50-degree field of view — 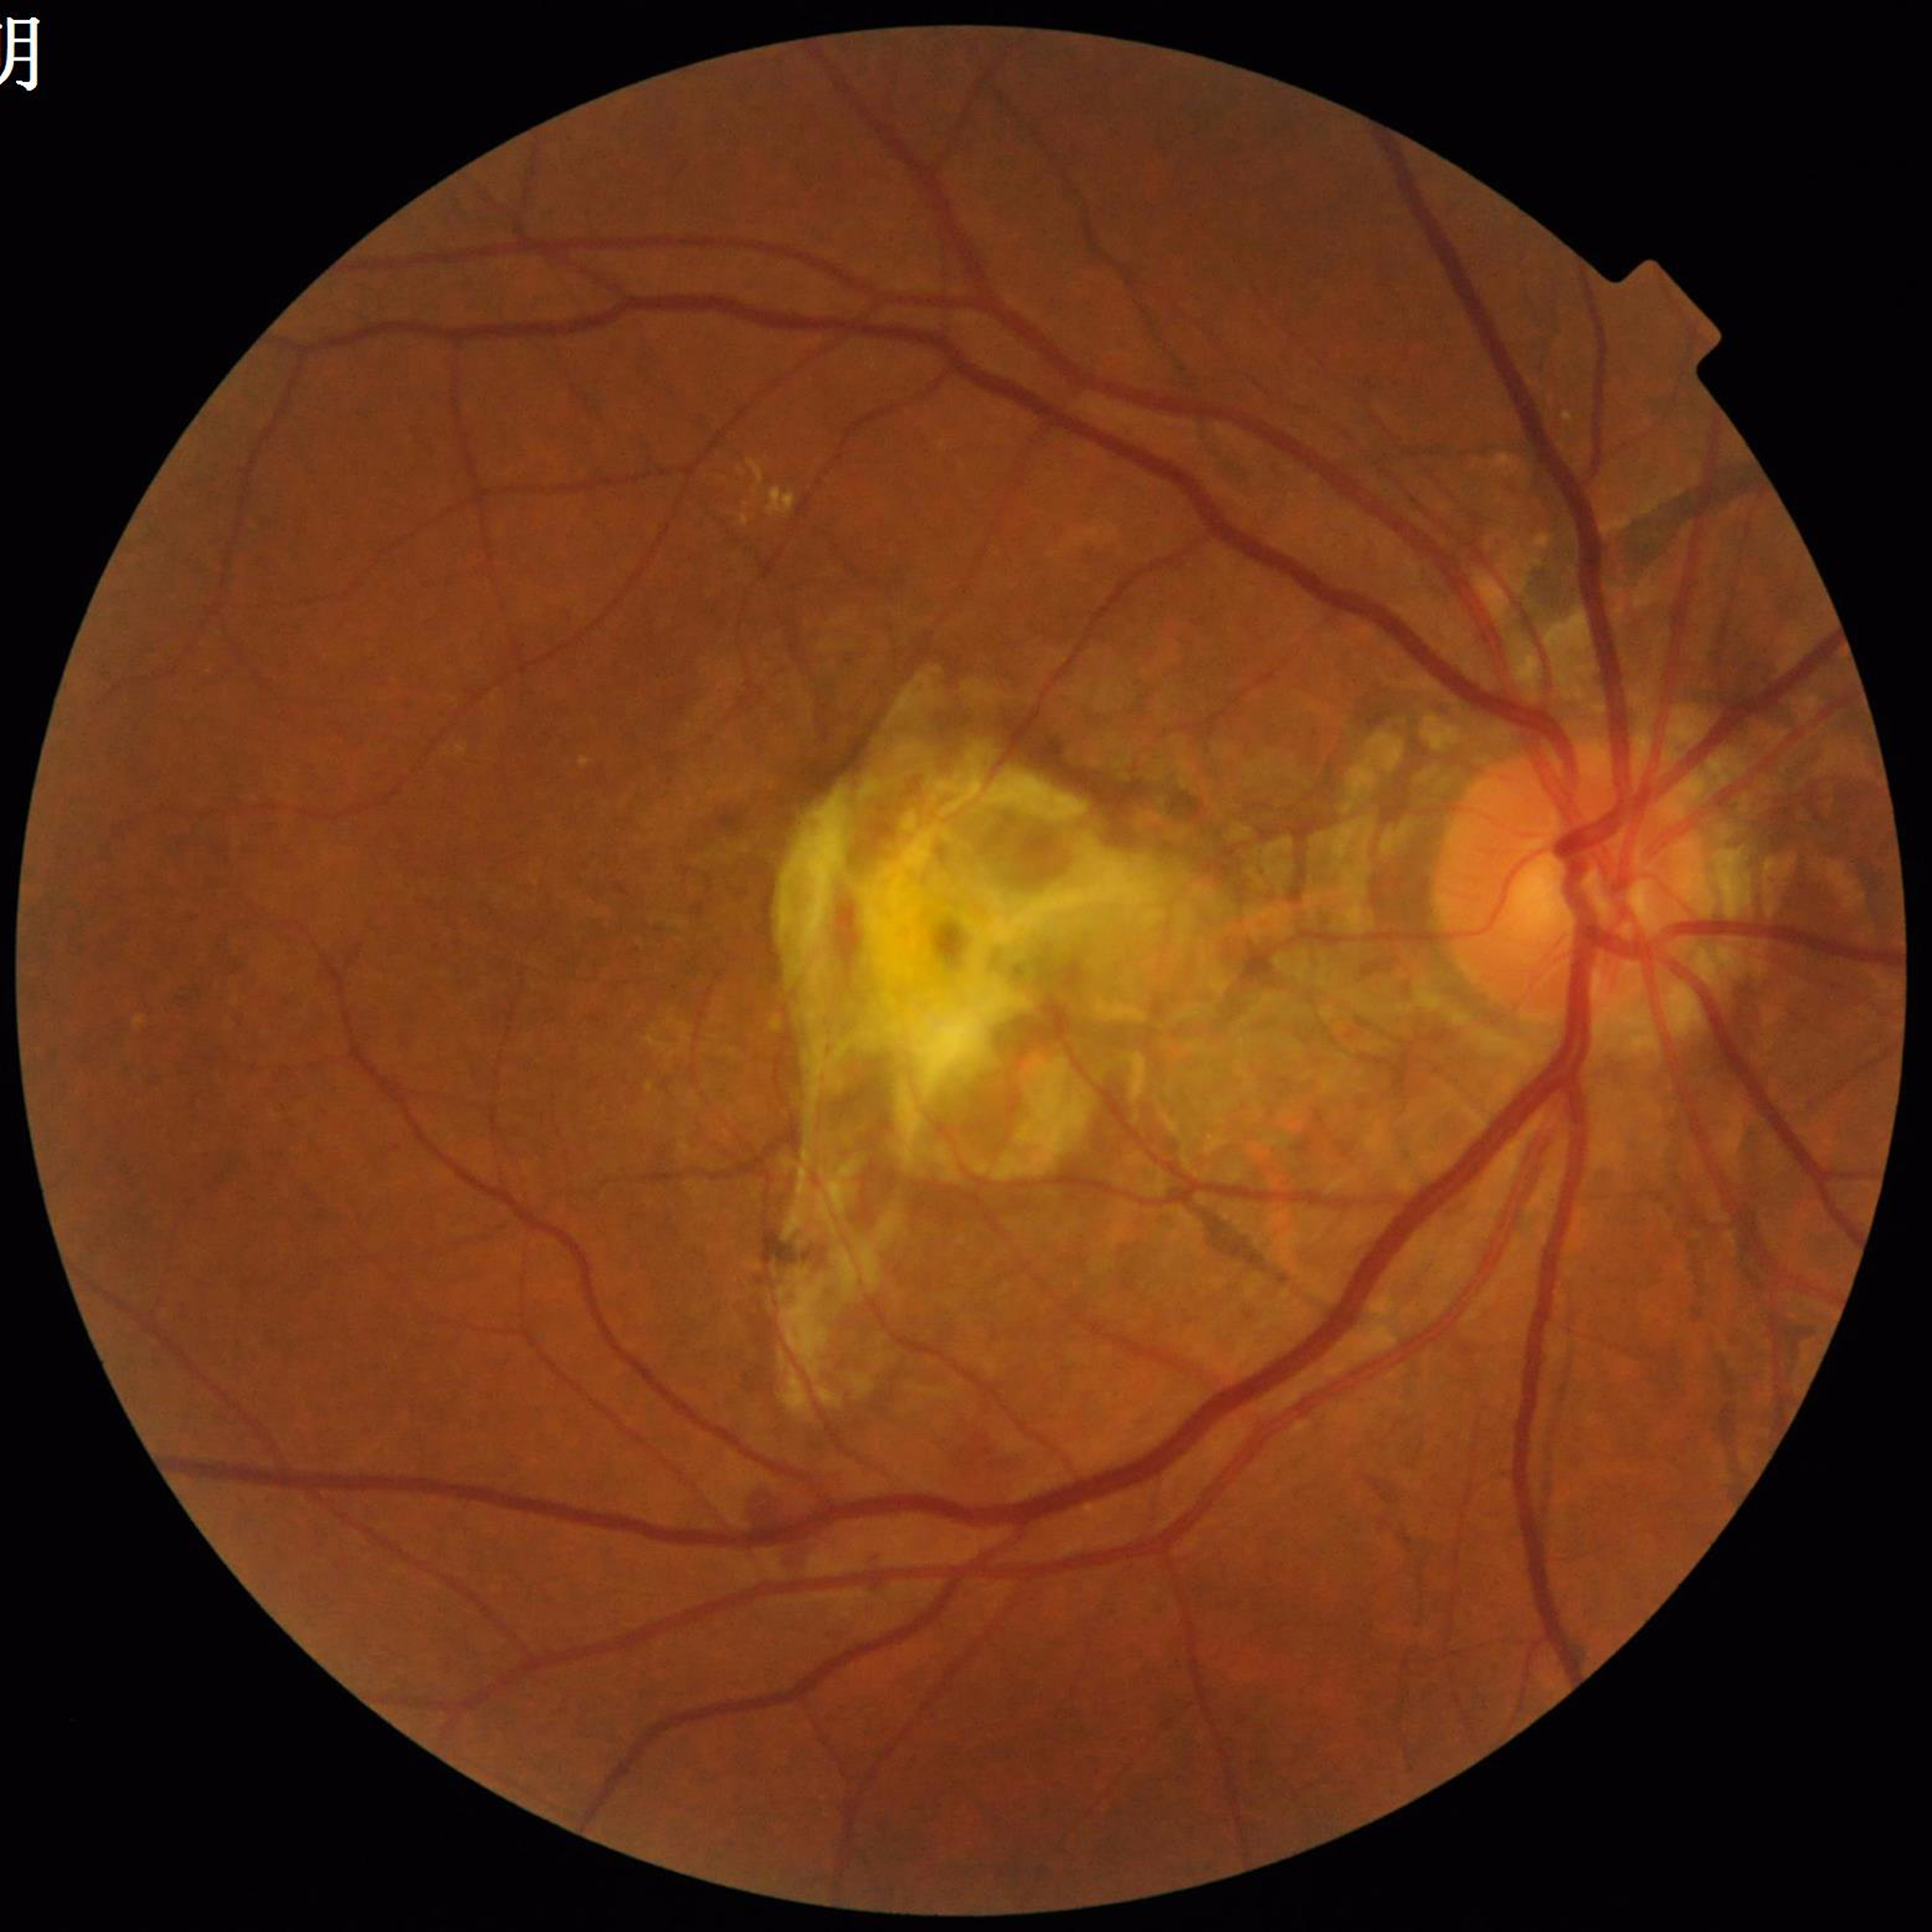

diagnosis: AMD